Wide-field fundus photograph from neonatal ROP screening. 130° field of view (Natus RetCam Envision) — 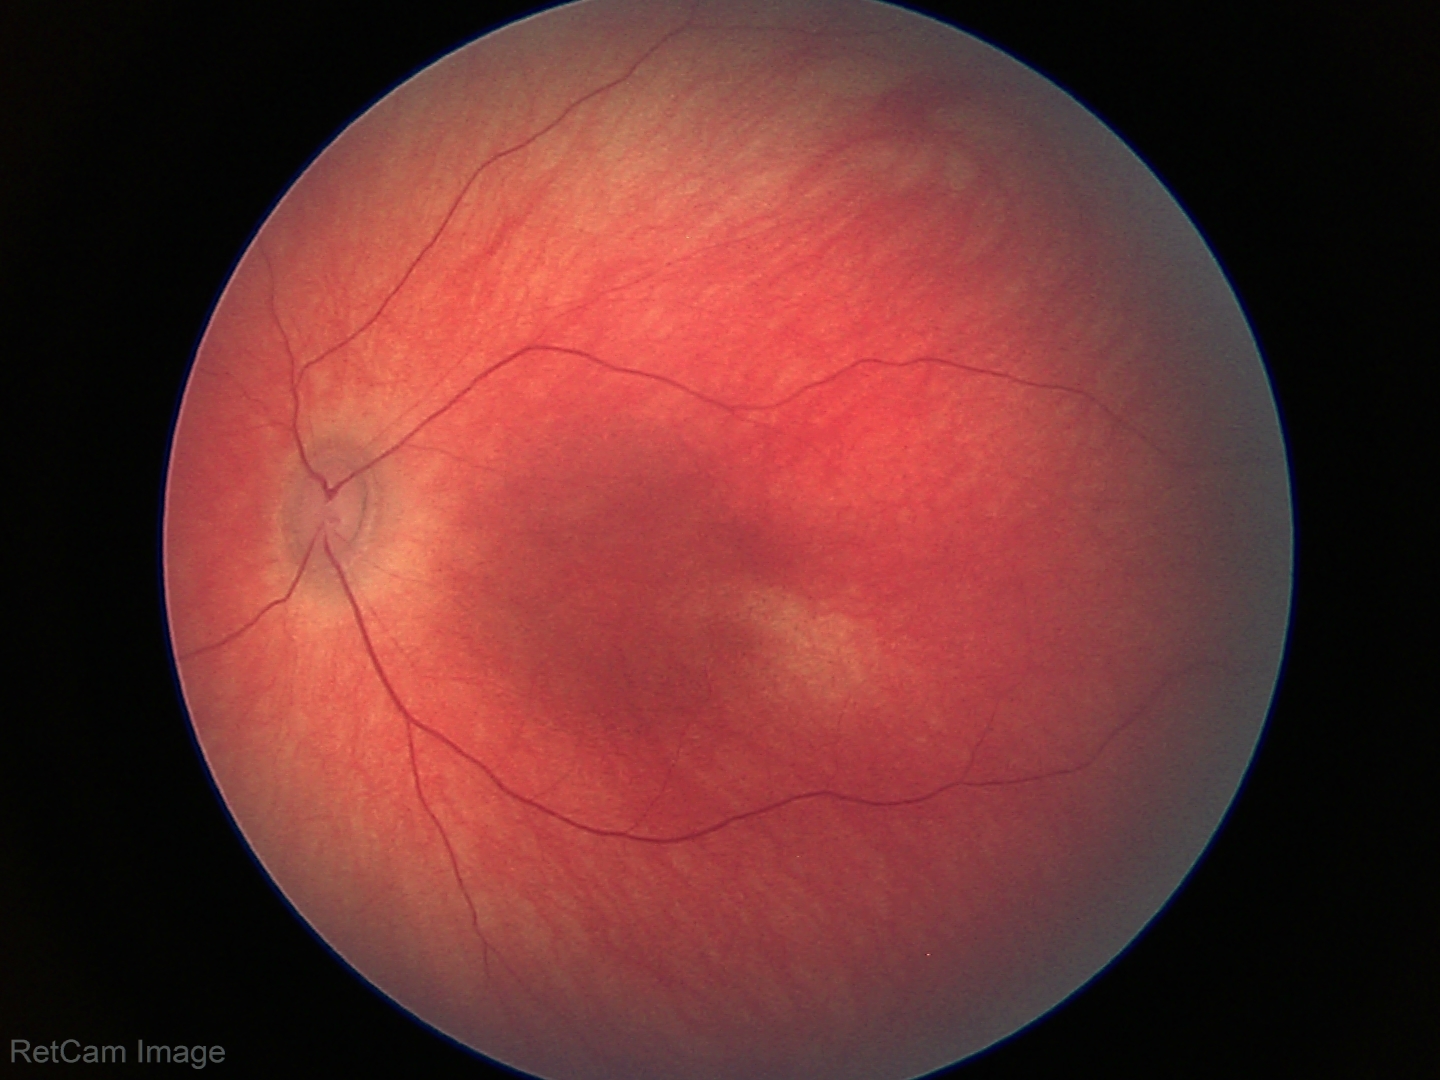
Assessment: physiological.